45-degree field of view:
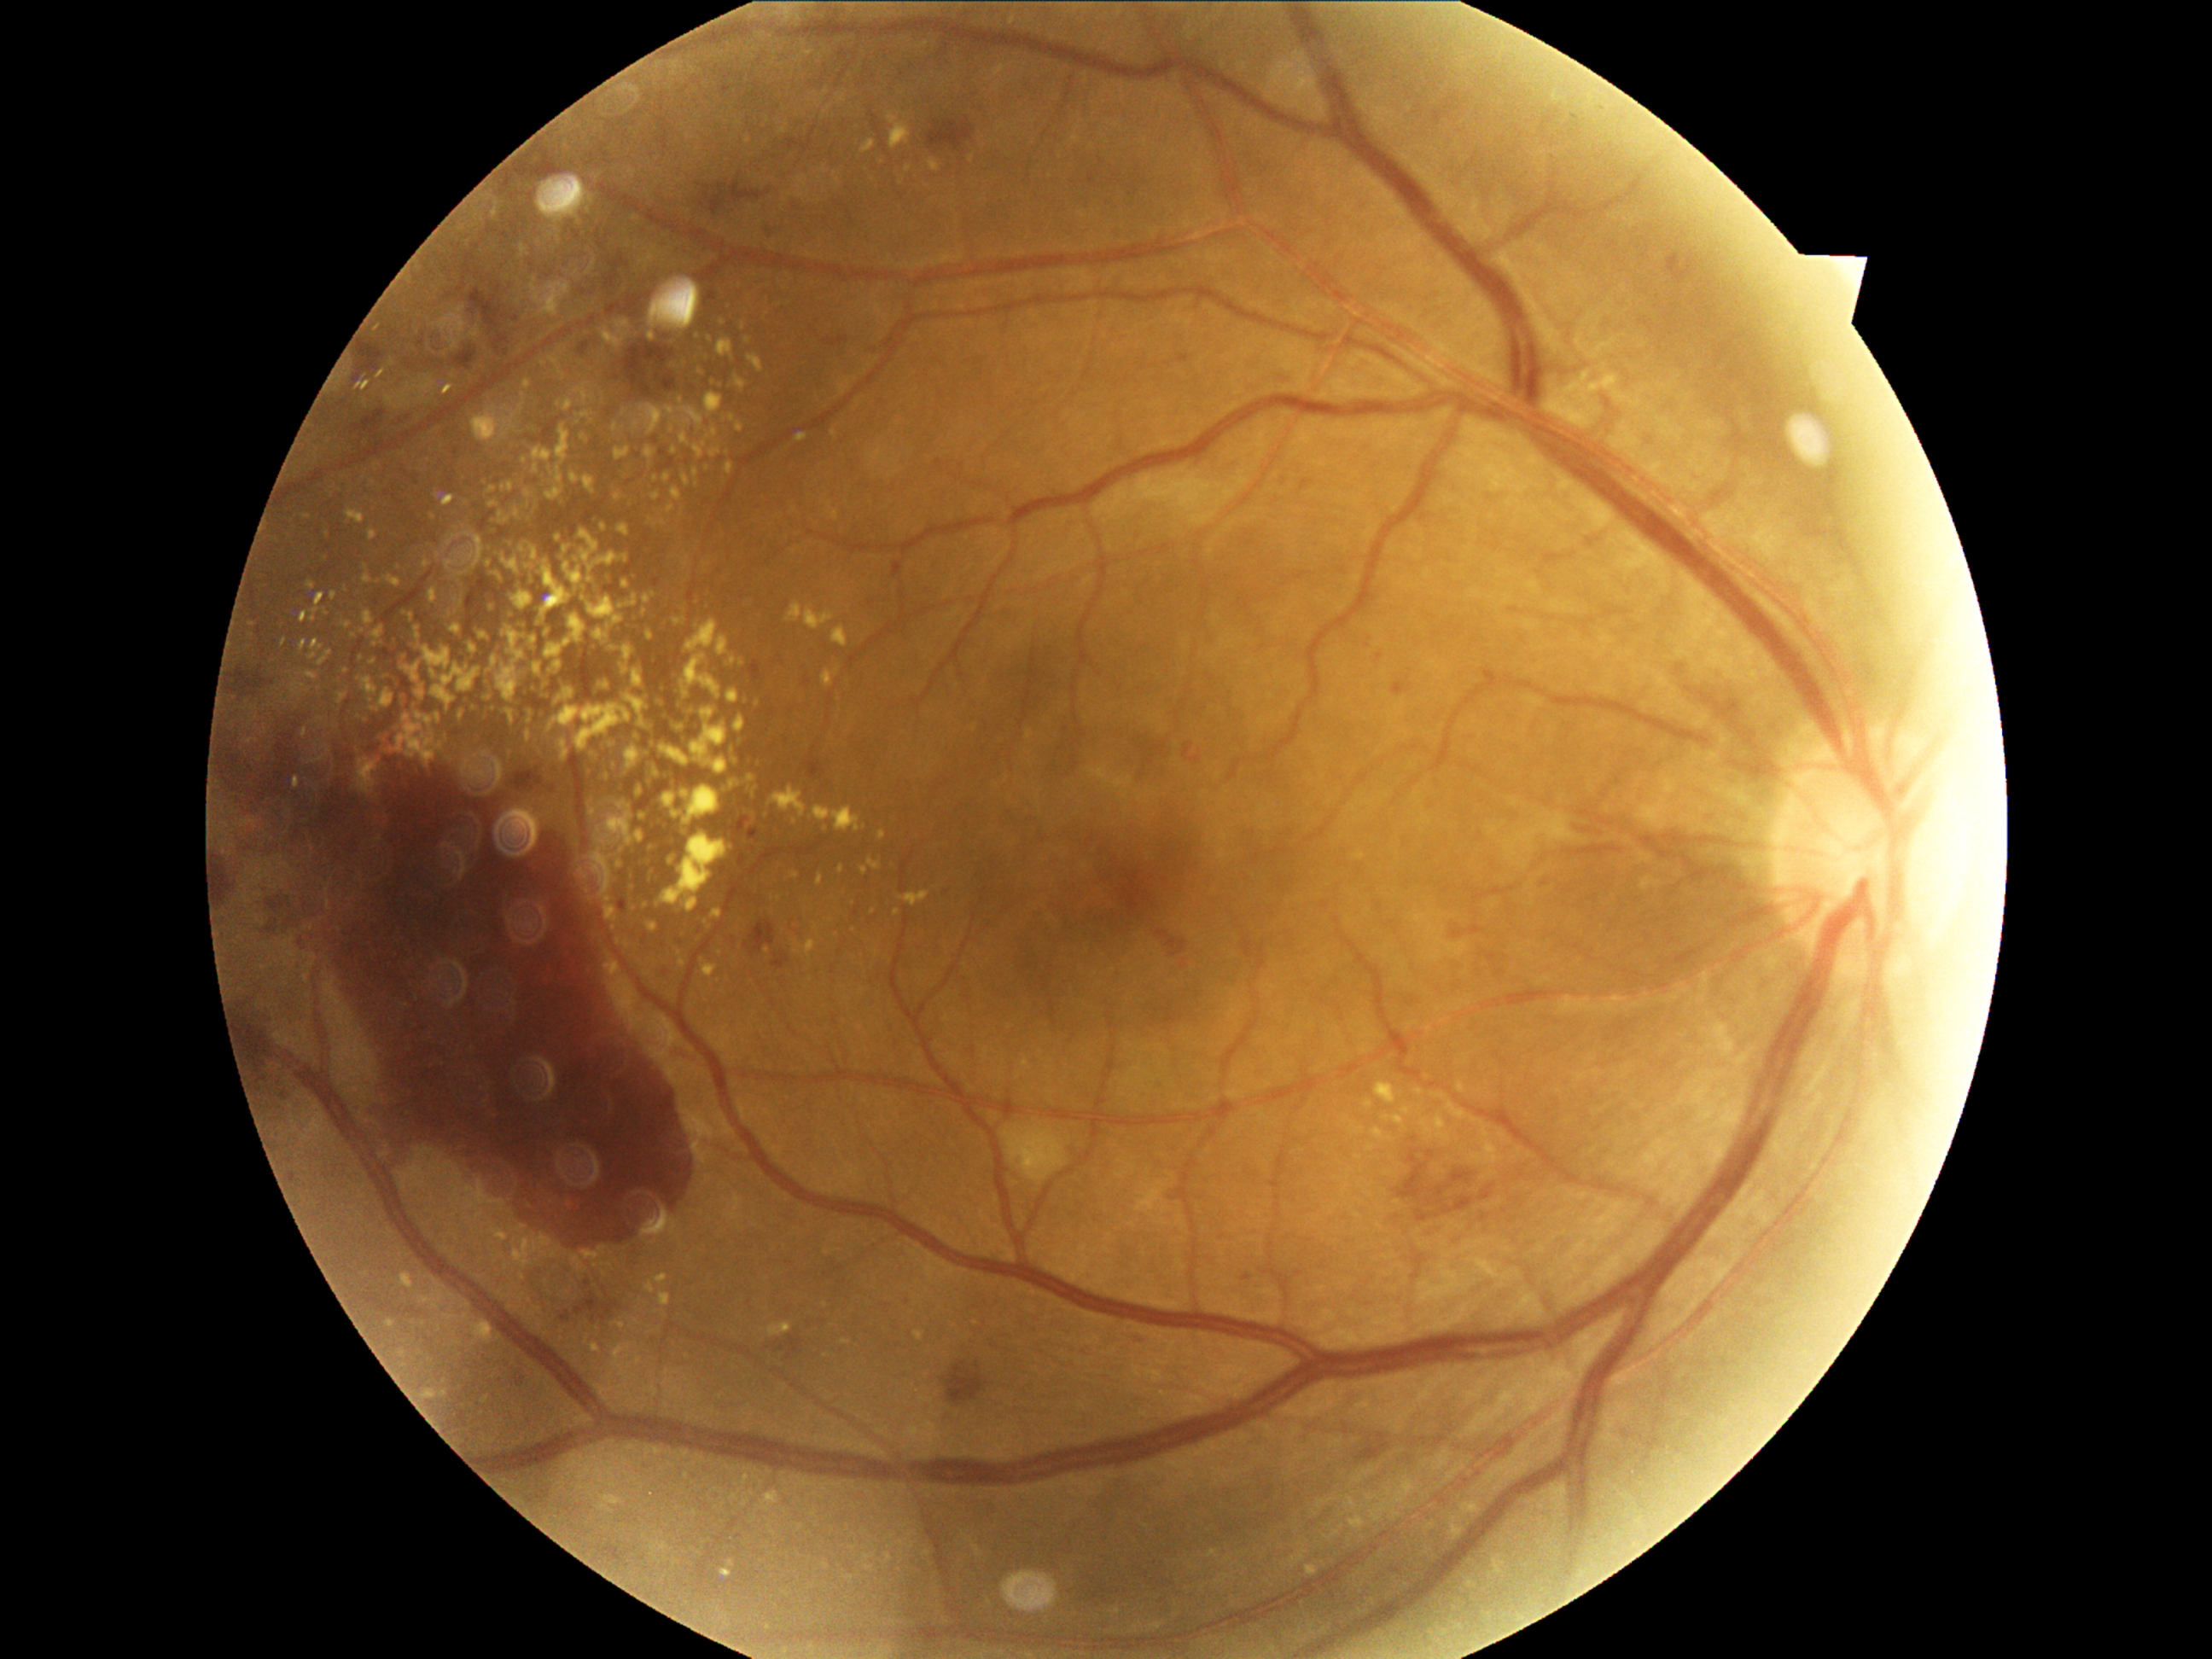
Diabetic retinopathy grade is 4. Hard exudates include lesions at rect(590, 586, 597, 602) | rect(1448, 1103, 1465, 1119) | rect(617, 322, 629, 327) | rect(527, 573, 530, 581) | rect(648, 924, 658, 933) | rect(371, 627, 385, 641) | rect(996, 67, 1004, 76) | rect(673, 812, 682, 818) | rect(1435, 1117, 1447, 1129) | rect(1375, 1085, 1397, 1103) | rect(849, 928, 858, 933) | rect(588, 597, 624, 624). Smaller hard exudates around {"x": 431, "y": 516} | {"x": 621, "y": 866} | {"x": 386, "y": 677} | {"x": 769, "y": 803} | {"x": 893, "y": 120} | {"x": 645, "y": 612} | {"x": 752, "y": 796}.